Macula at the center of the field.
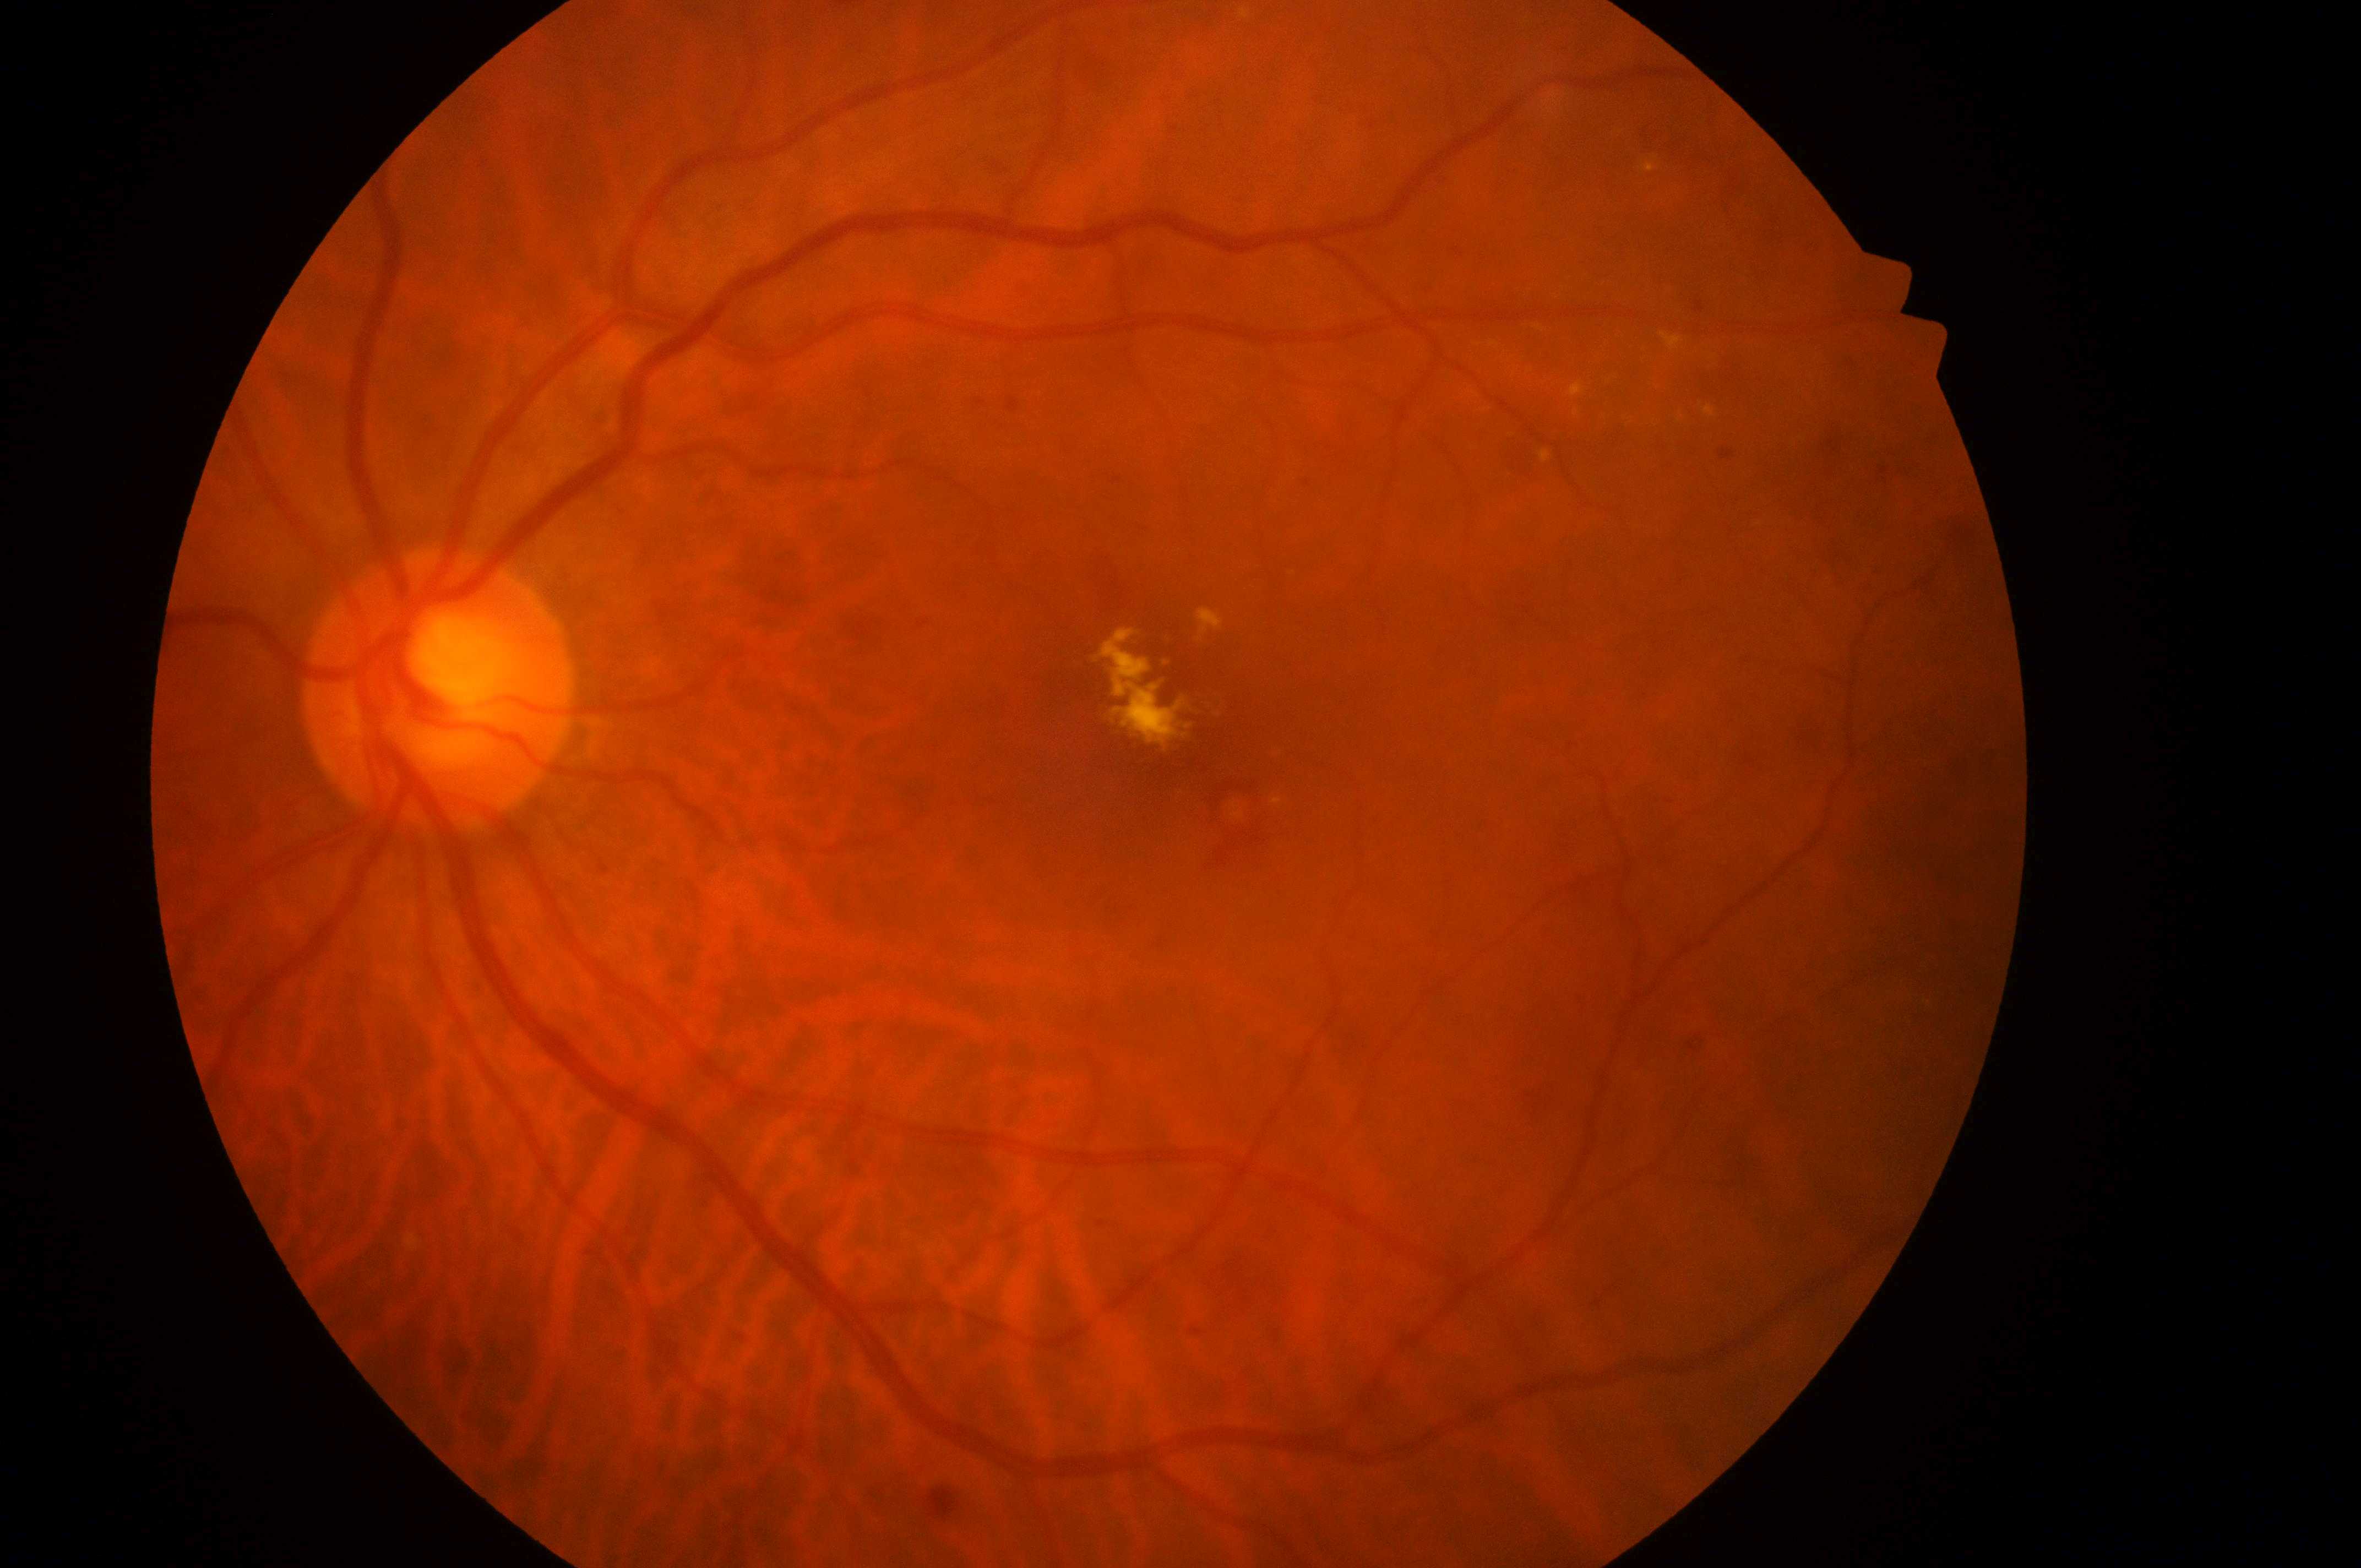 – ONH — (x=429, y=699)
– macular edema — 2 — hard exudates within one disc diameter of the macula center
– foveal center — (x=1161, y=744)
– retinopathy — grade 2 — more than just microaneurysms but less than severe NPDR
– laterality — the left eye